Image size 2048x1536, FOV: 45 degrees: 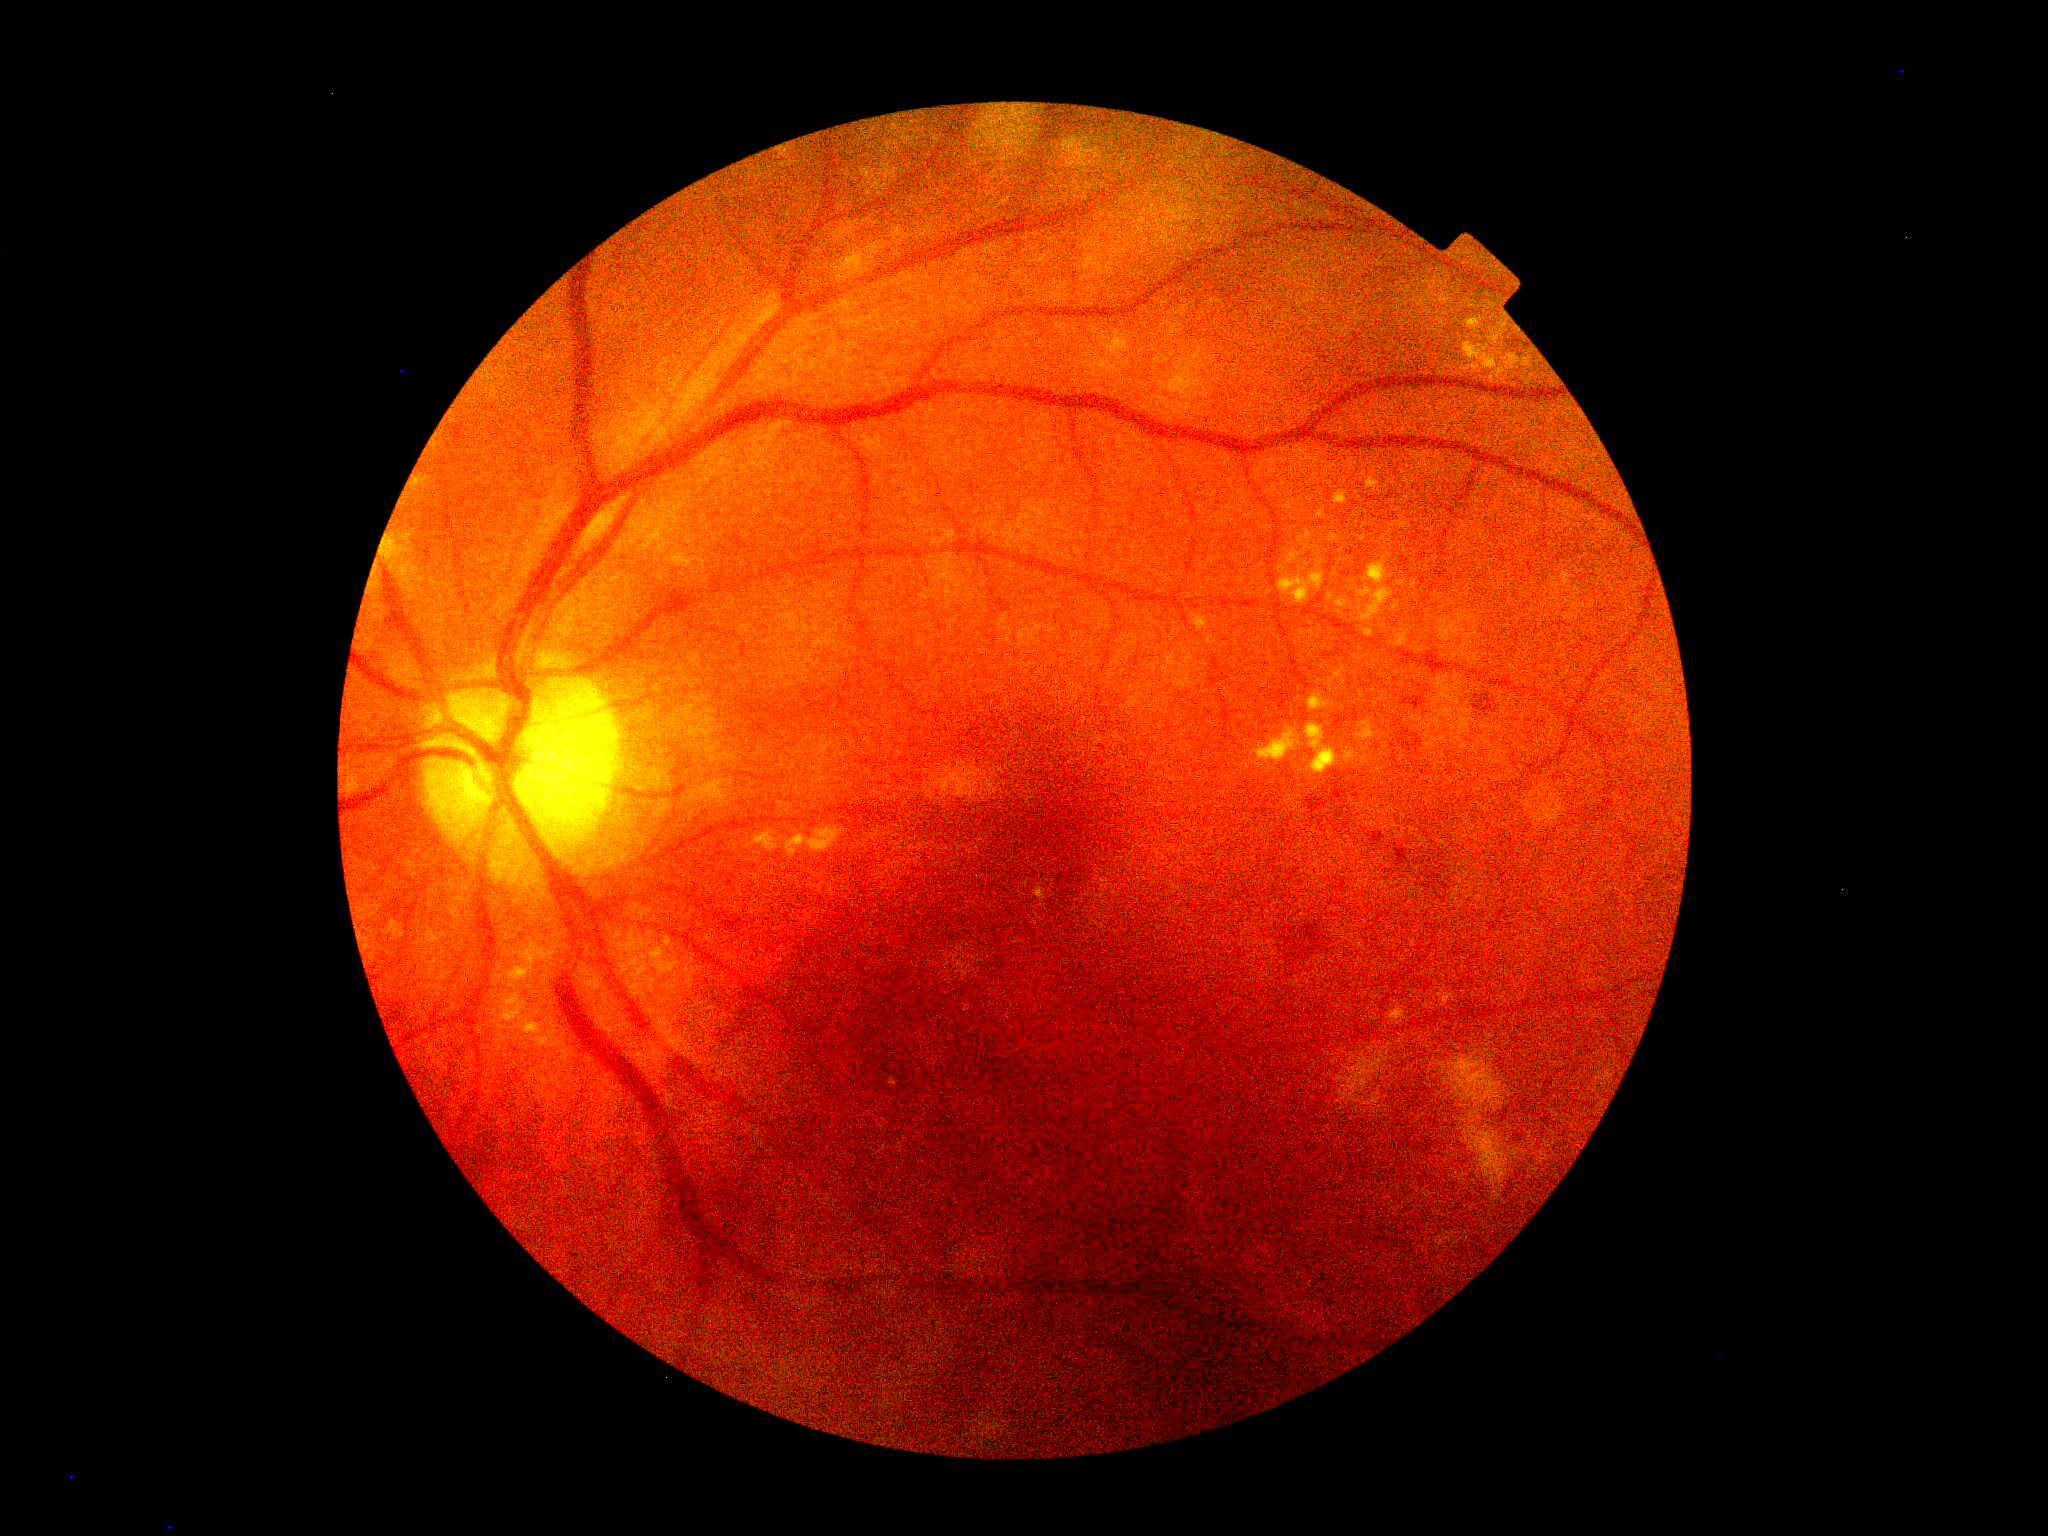 DR class: non-proliferative diabetic retinopathy. DR stage is grade 2 (moderate NPDR).